Color fundus image — 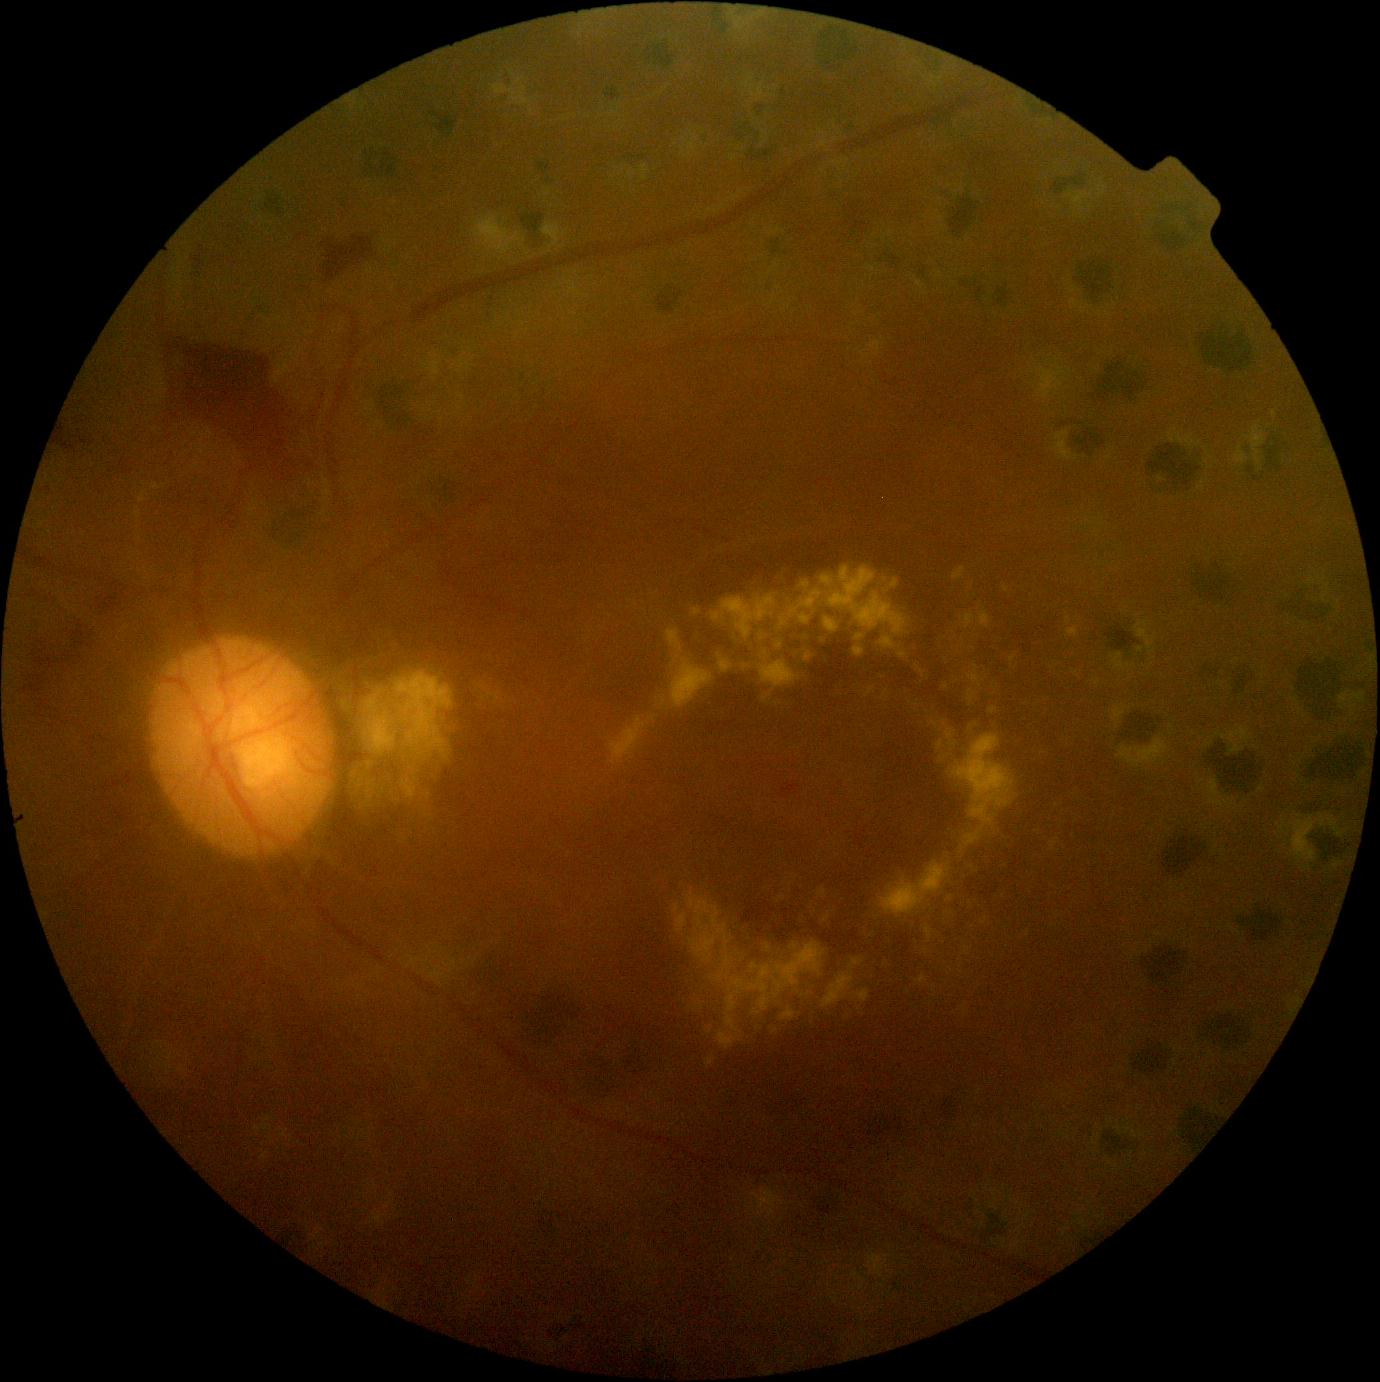
DR: grade 4 (PDR).